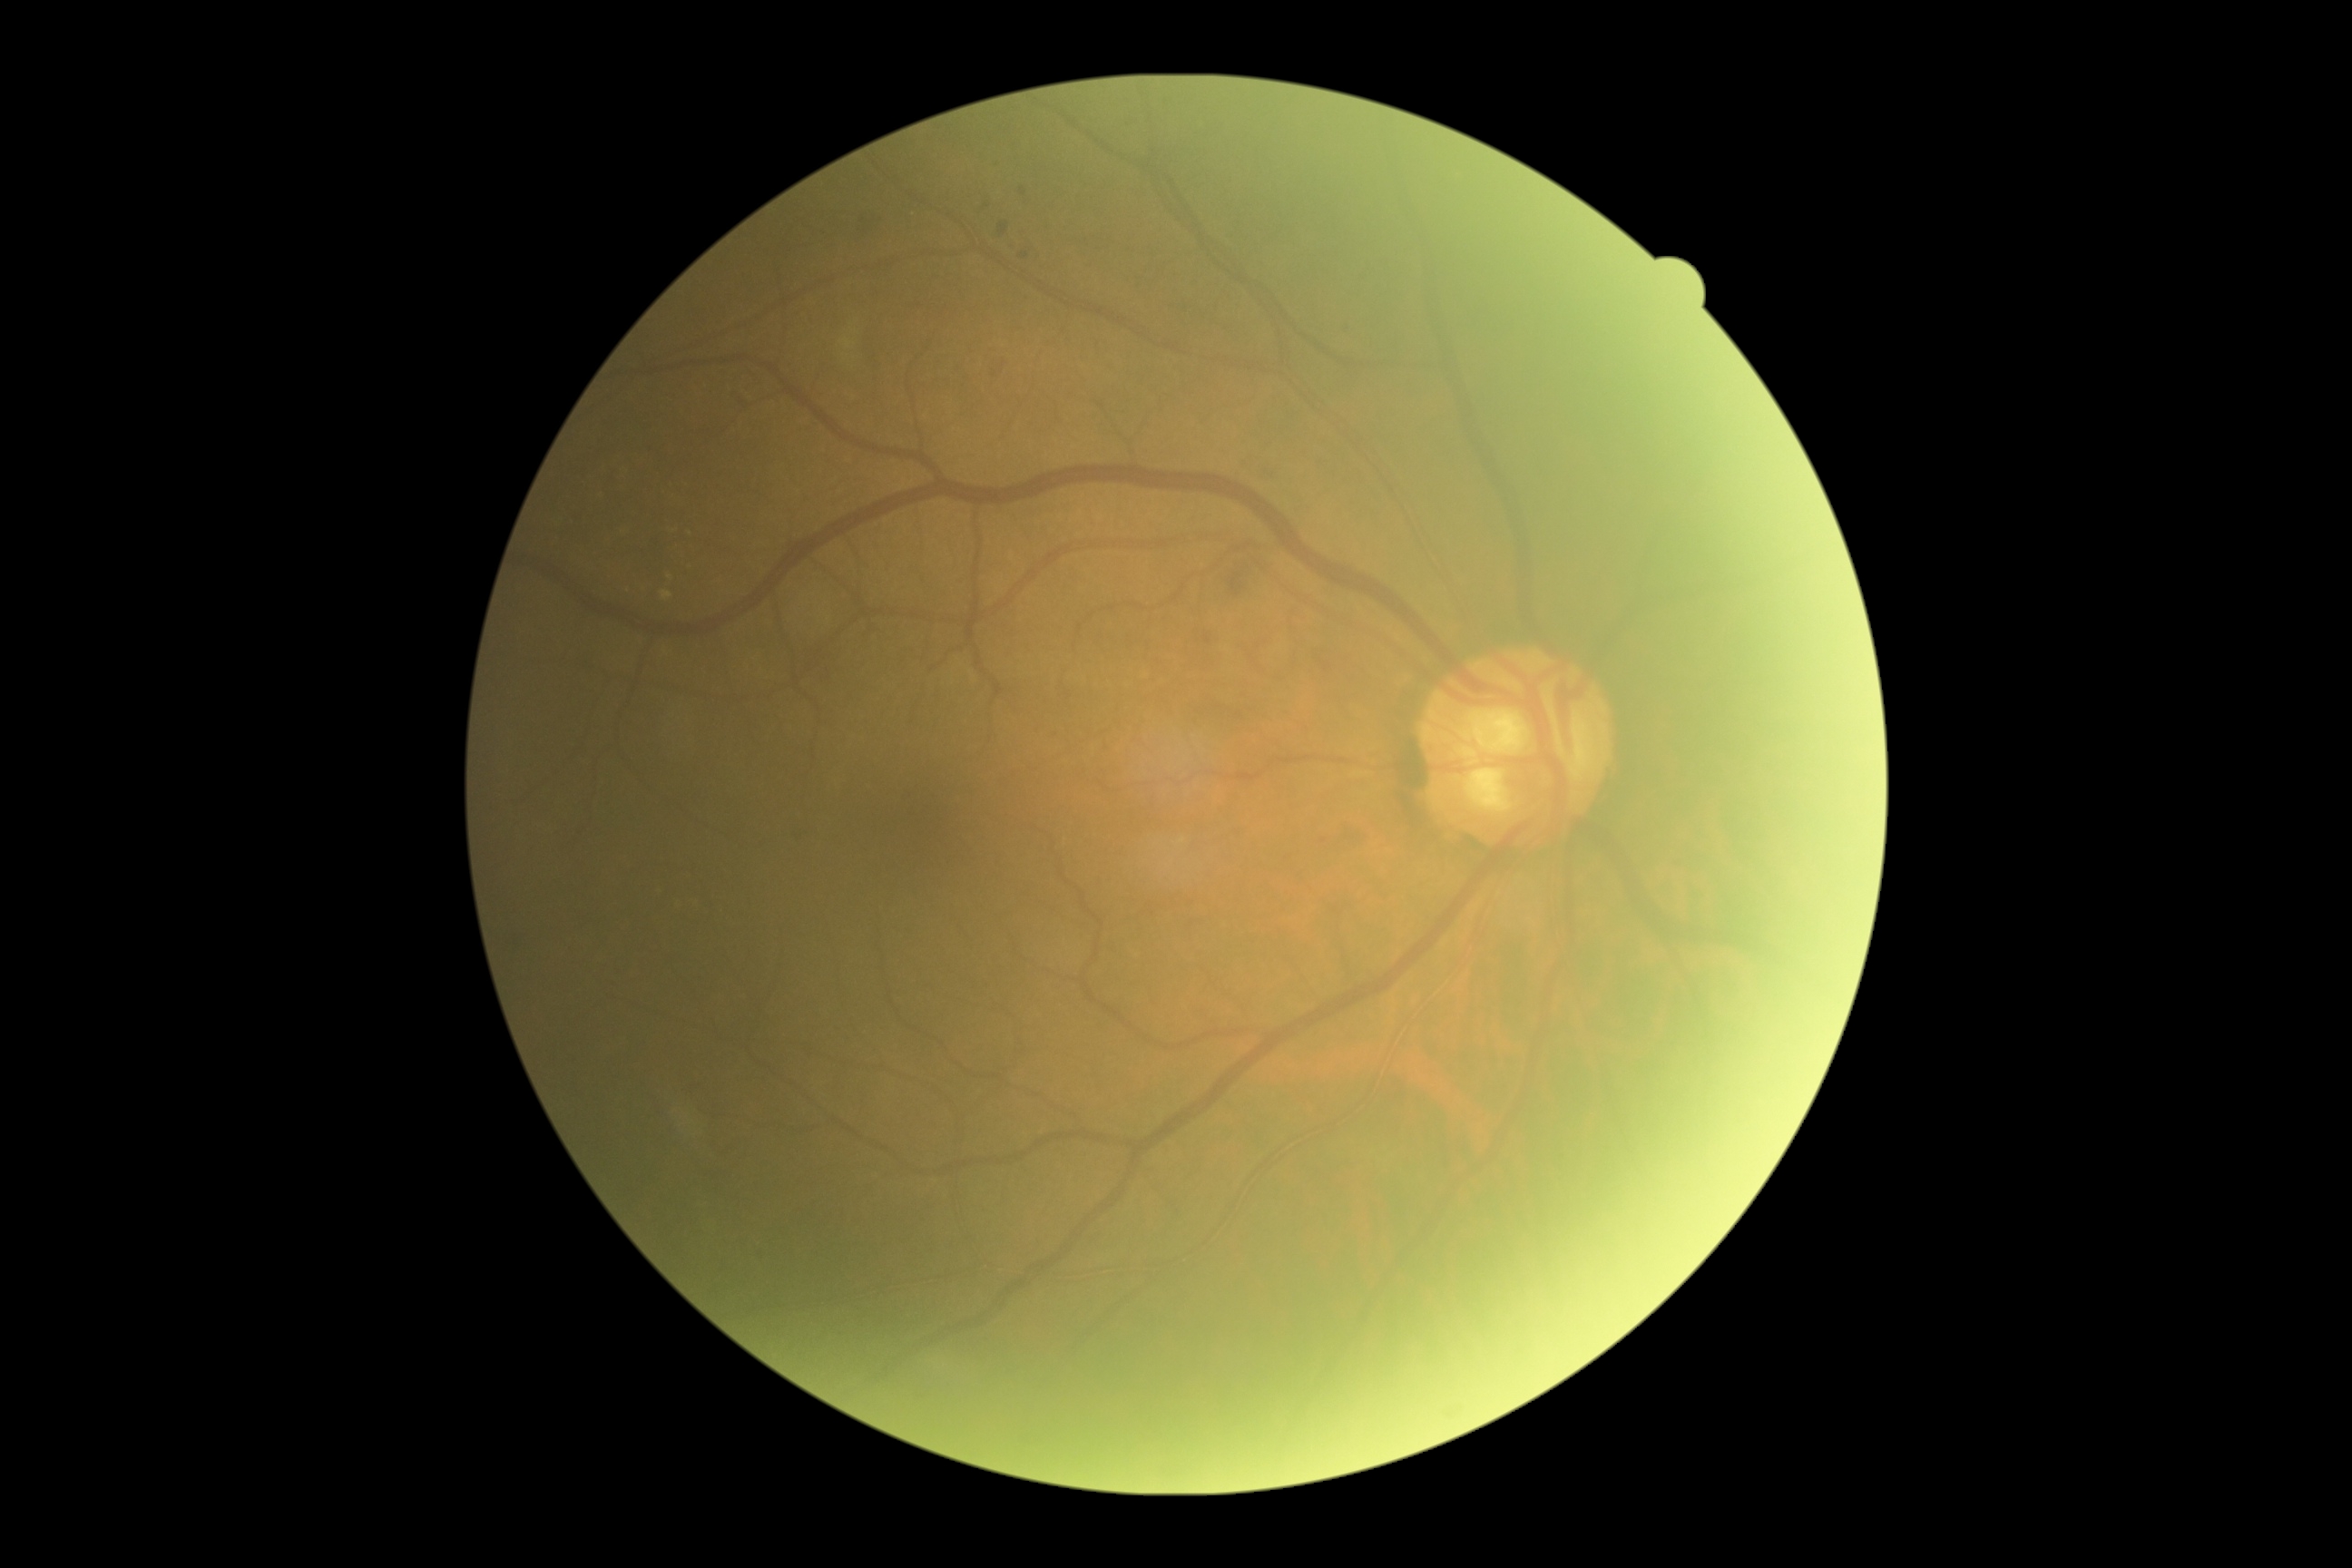

Retinopathy grade is moderate NPDR (2).